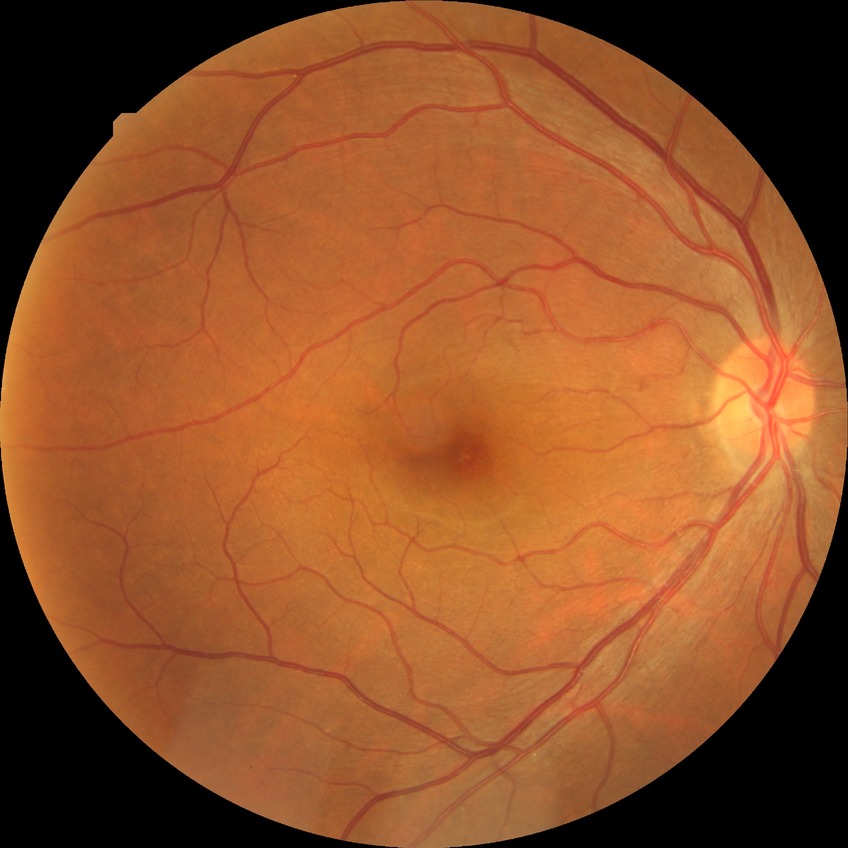 Davis stage@NDR.